45° field of view; color fundus photograph; image size 2212x1659.
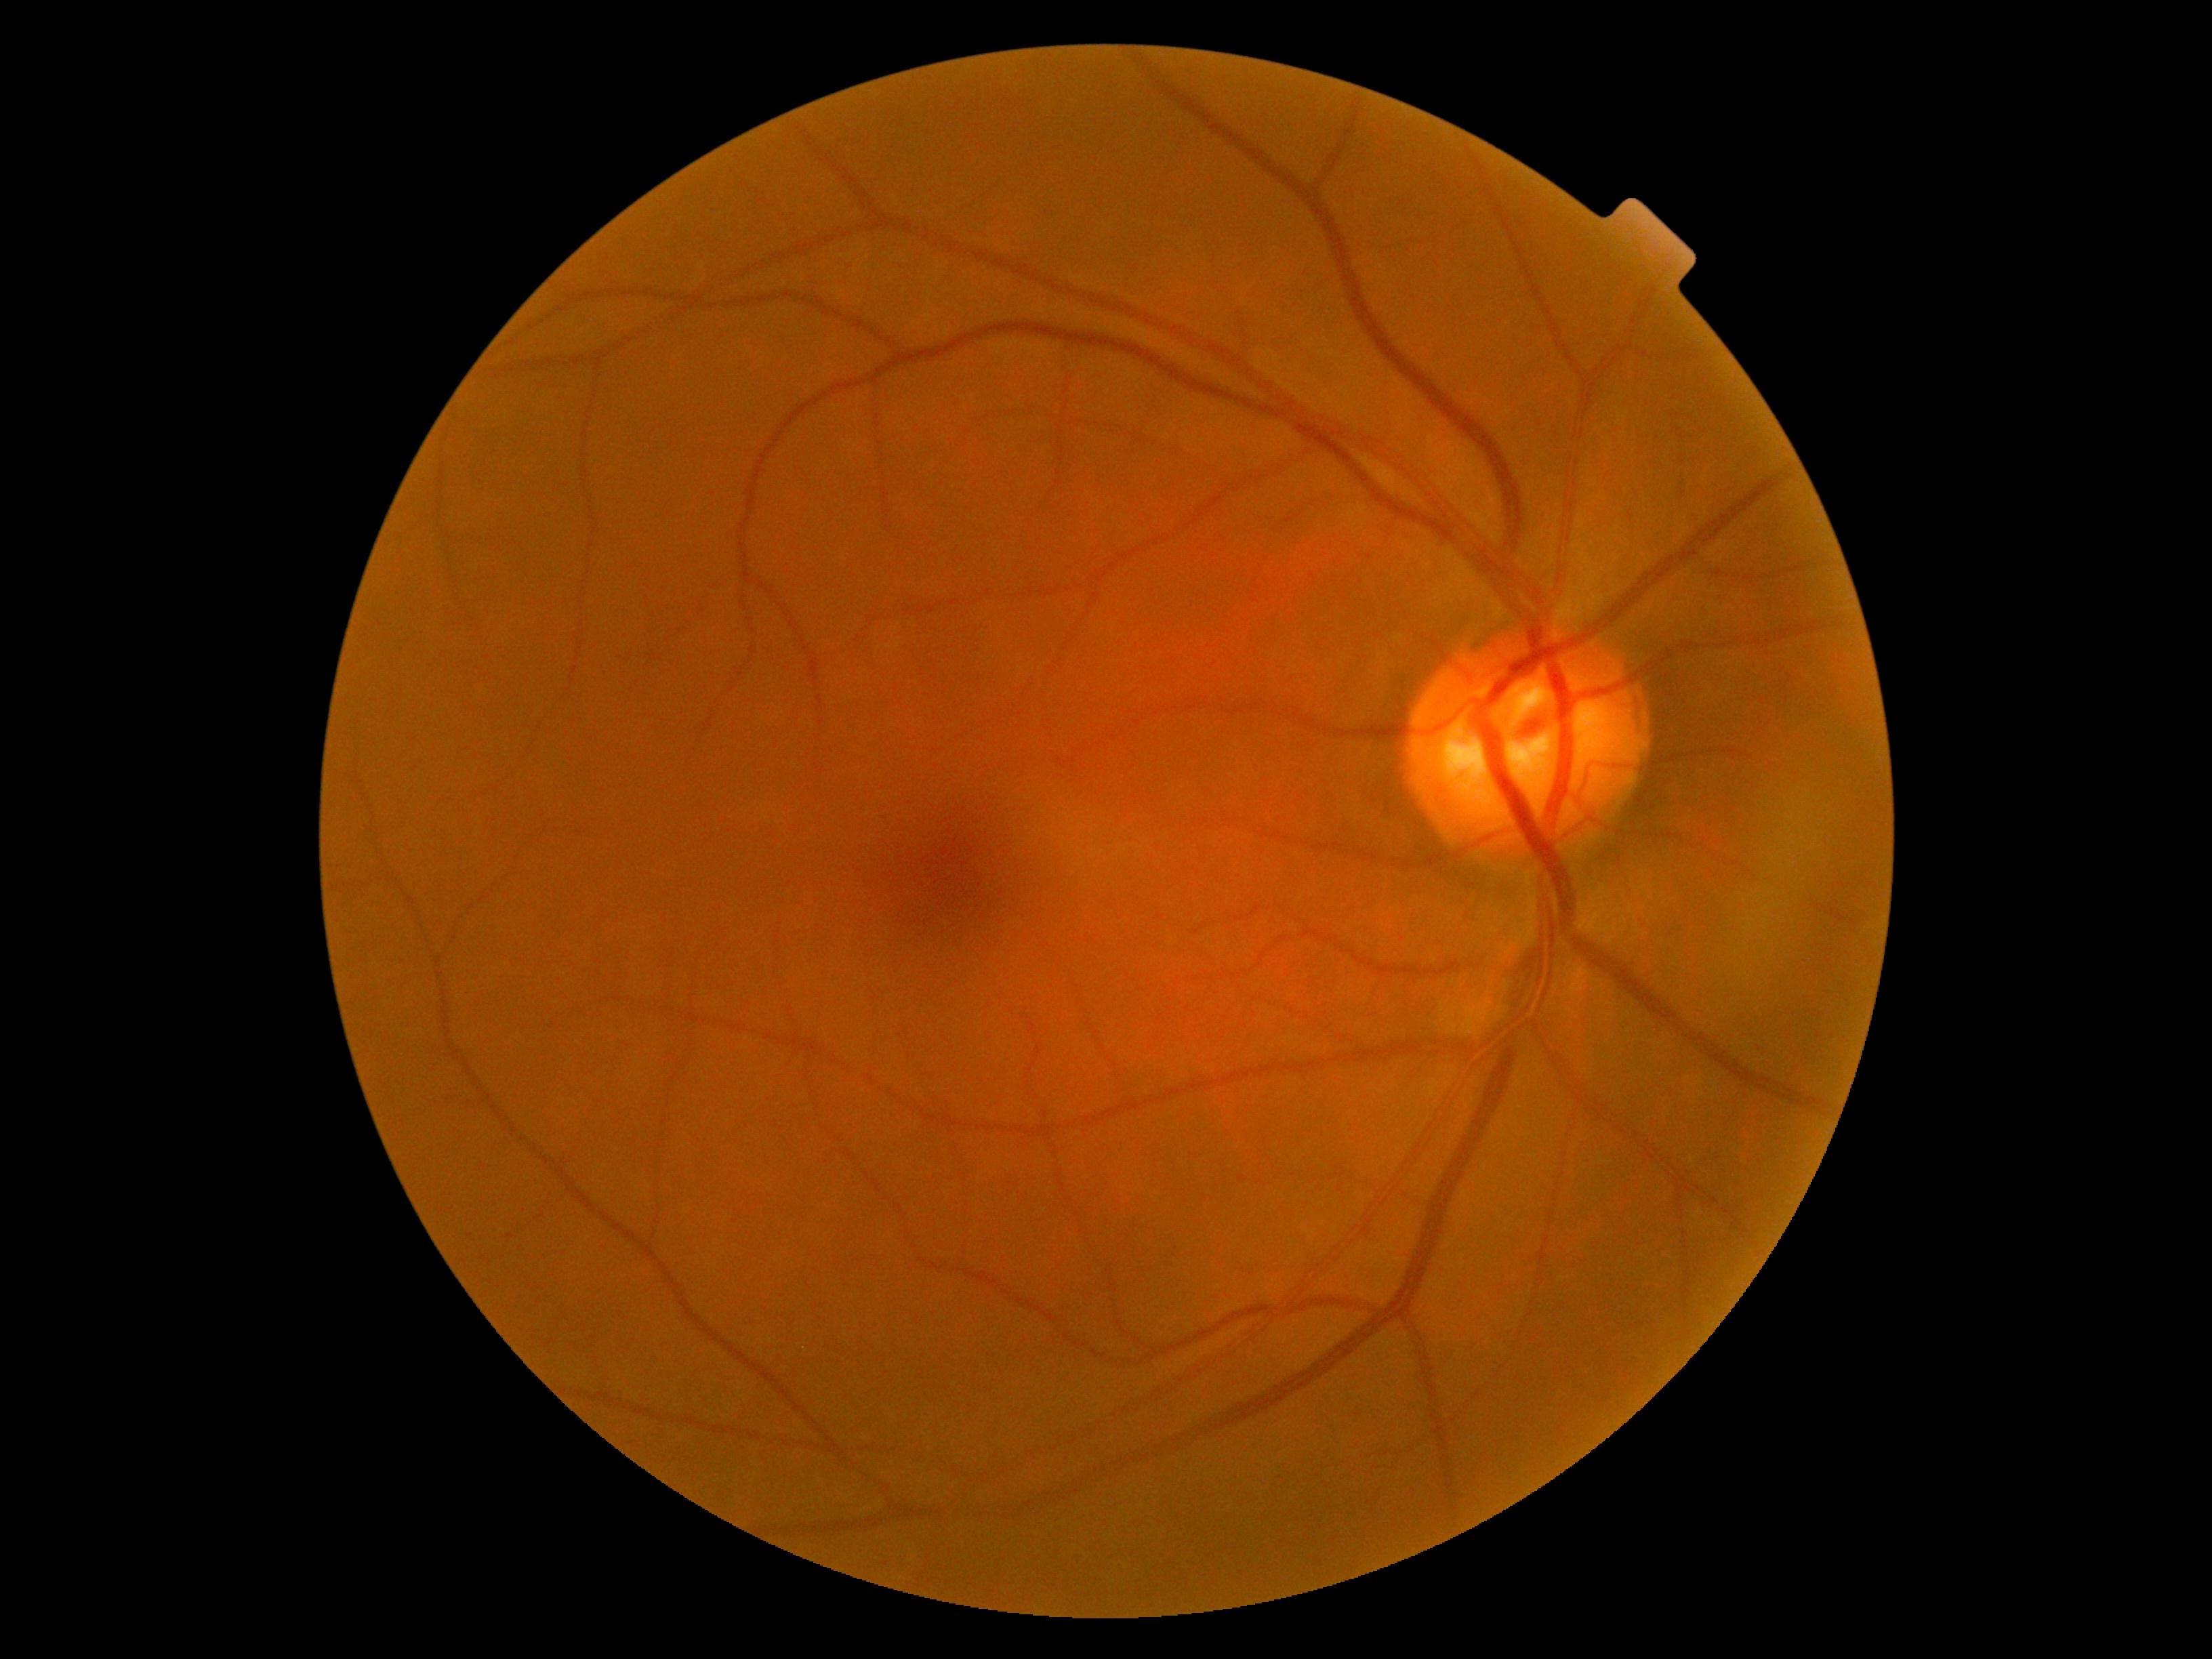

Findings:
* DR severity — grade 0 (no apparent retinopathy)